No pharmacologic dilation, NIDEK AFC-230, posterior pole color fundus photograph — 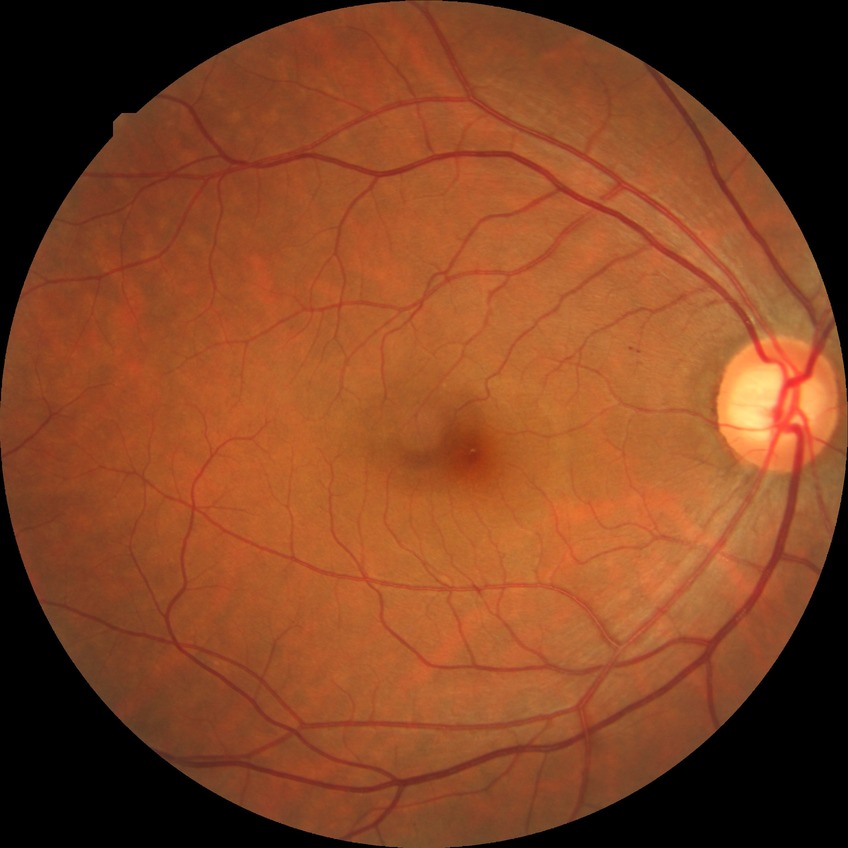

- diabetic retinopathy (DR): no diabetic retinopathy (NDR)